DR severity per modified Davis staging; FOV: 45 degrees:
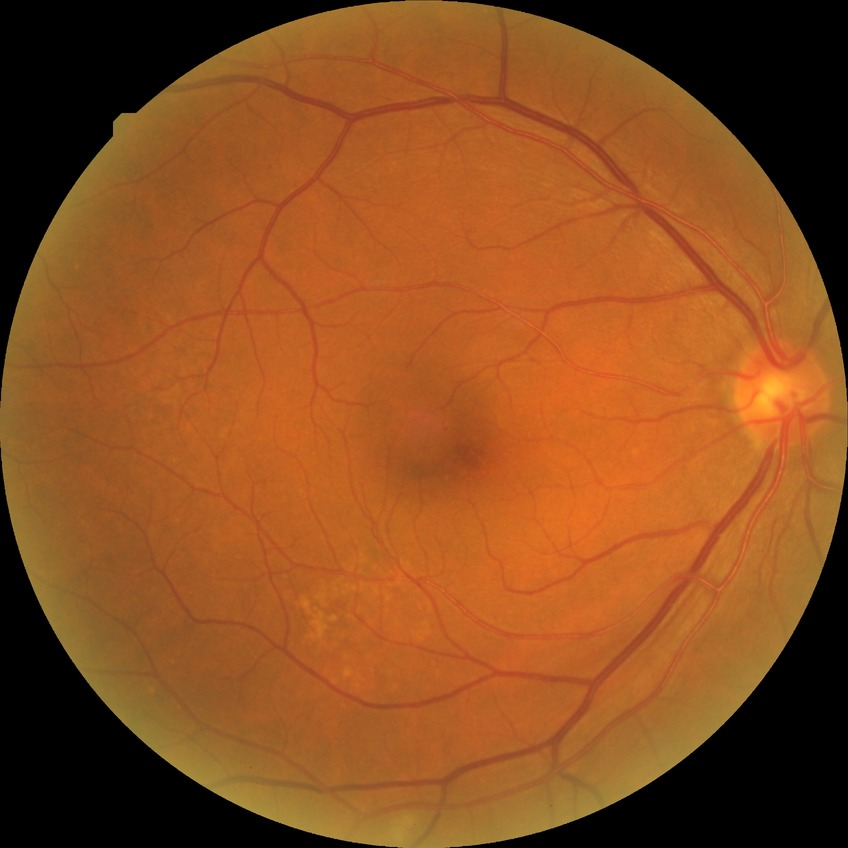
diabetic retinopathy (DR) = NDR (no diabetic retinopathy).